Image size 1932x1916; color fundus photograph; 45° FOV:
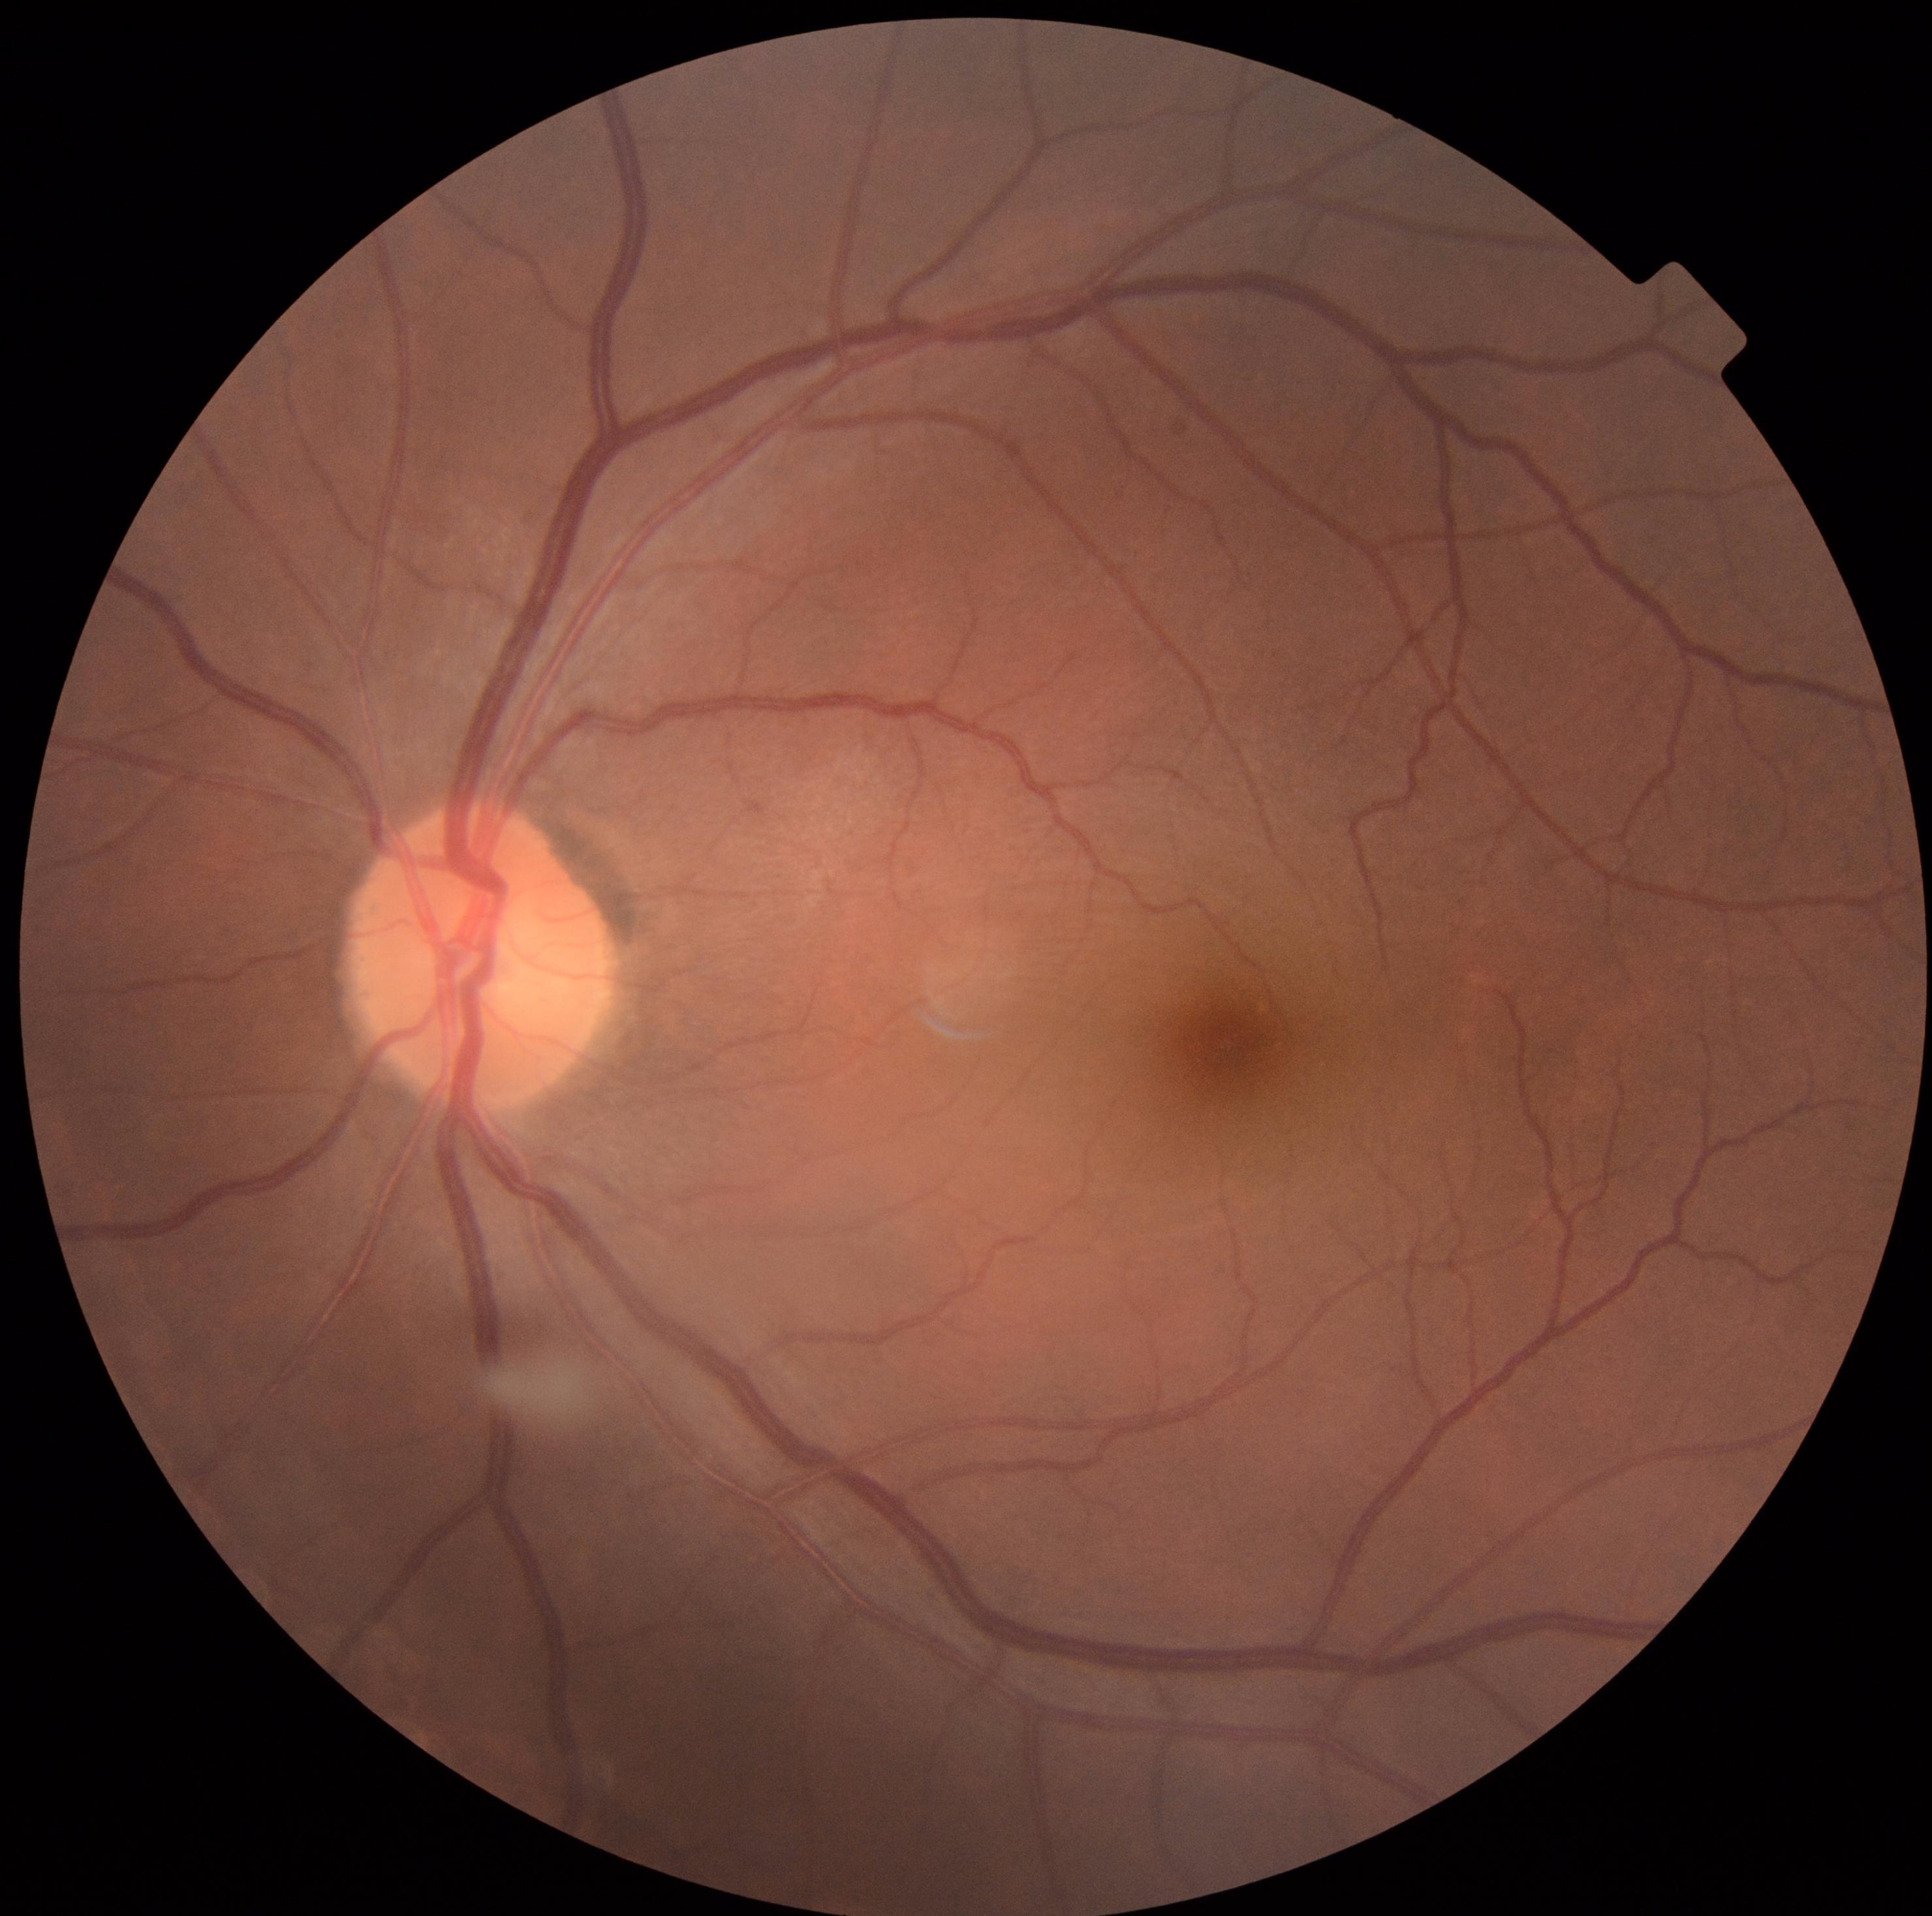
diabetic retinopathy severity: grade 0